1240 x 1240 pixels; infant wide-field retinal image; Phoenix ICON, 100° FOV: 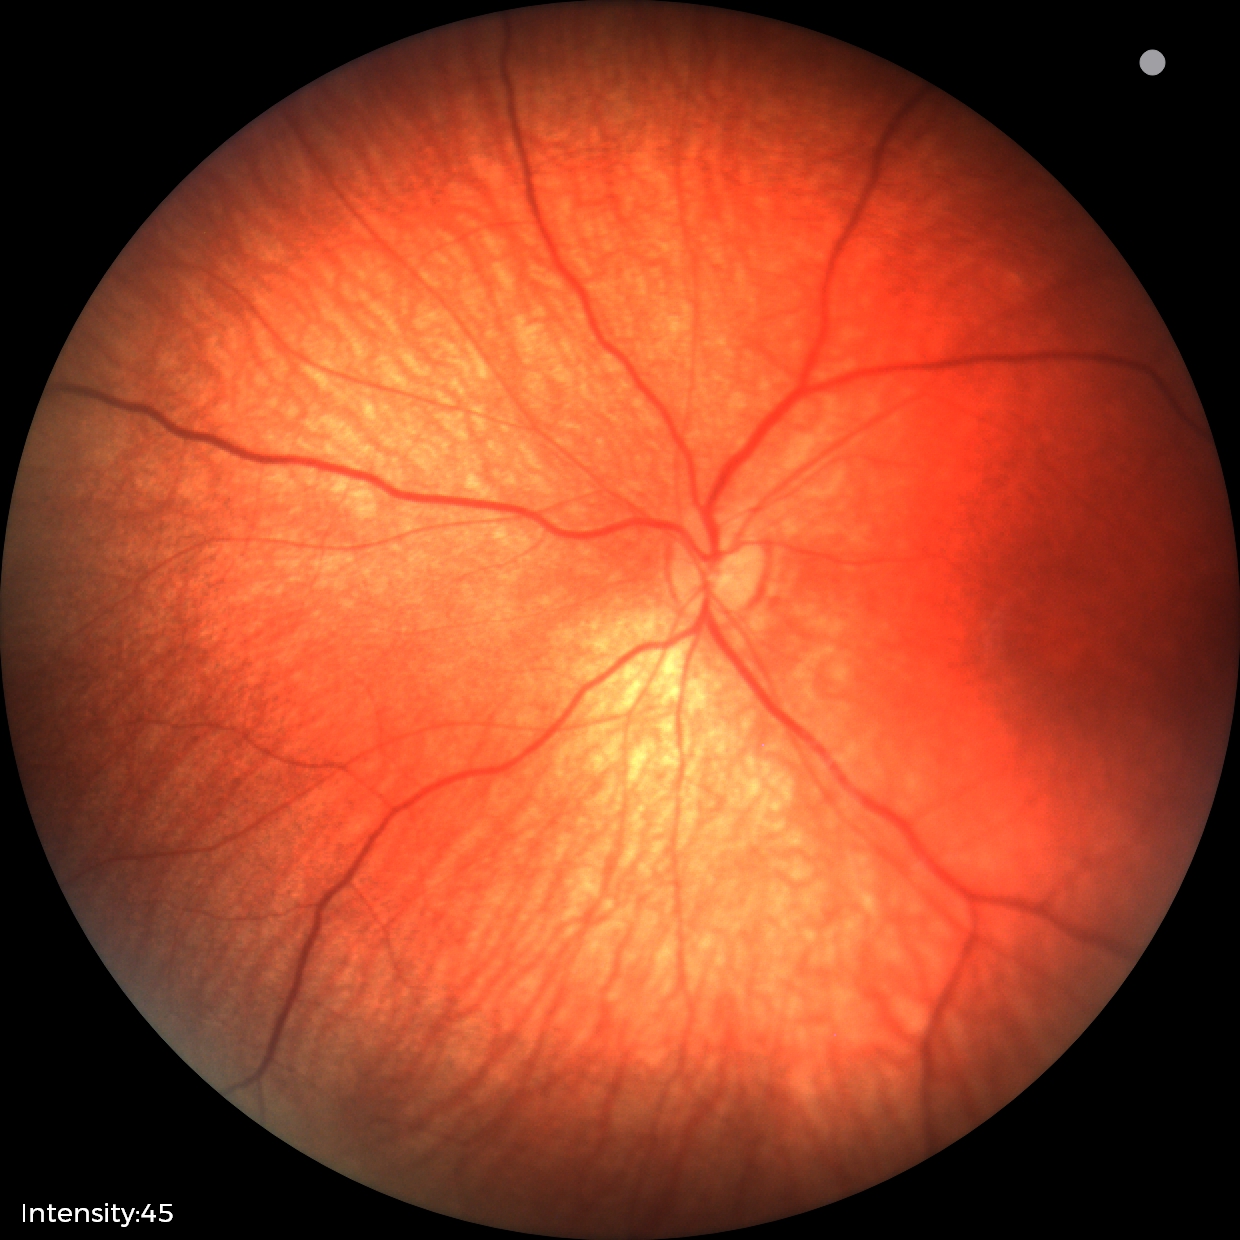

Q: What is the screening diagnosis?
A: physiological appearance with no retinal pathology